2048 x 1536 pixels.
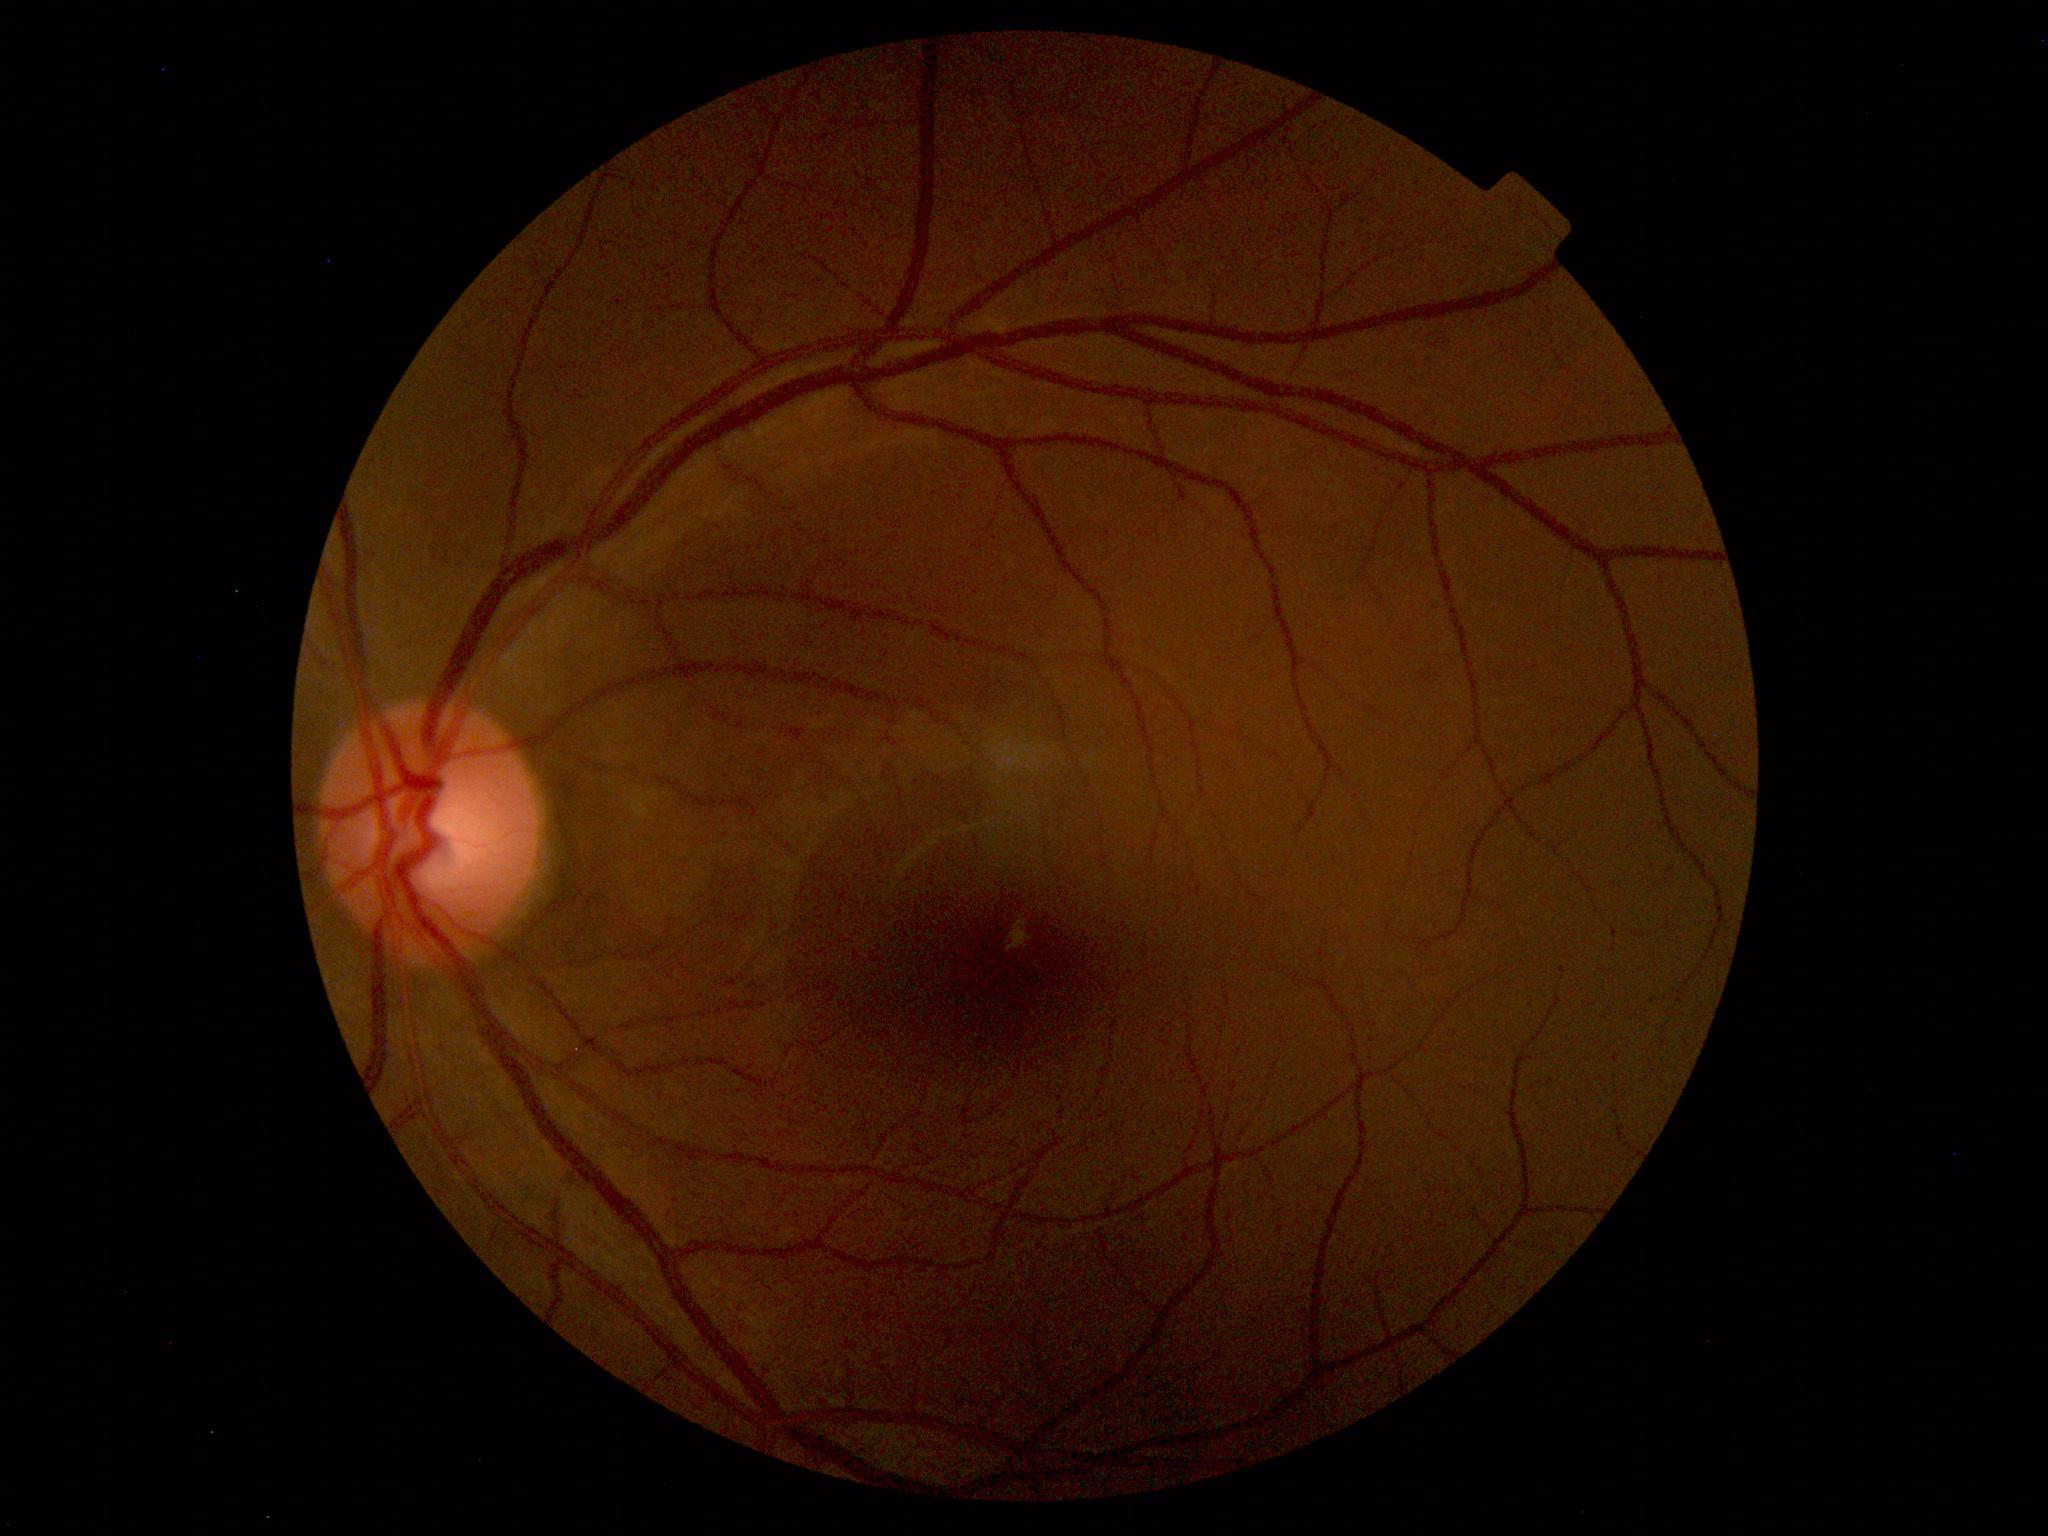 Normal fundus. No pathology identified.